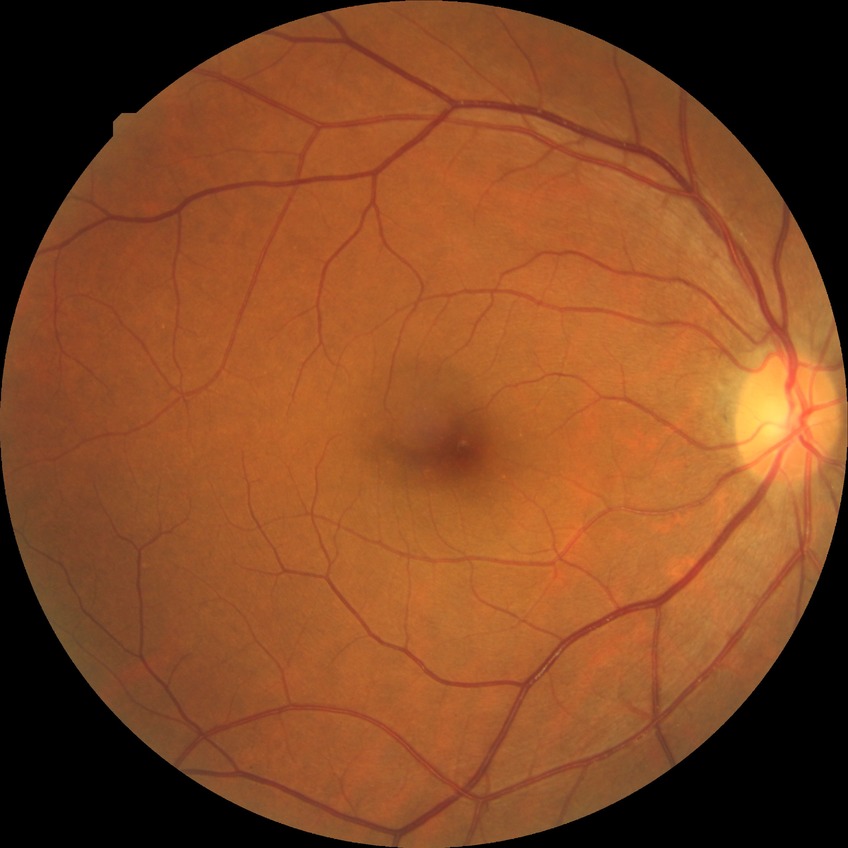
{"davis_grade": "no diabetic retinopathy"}